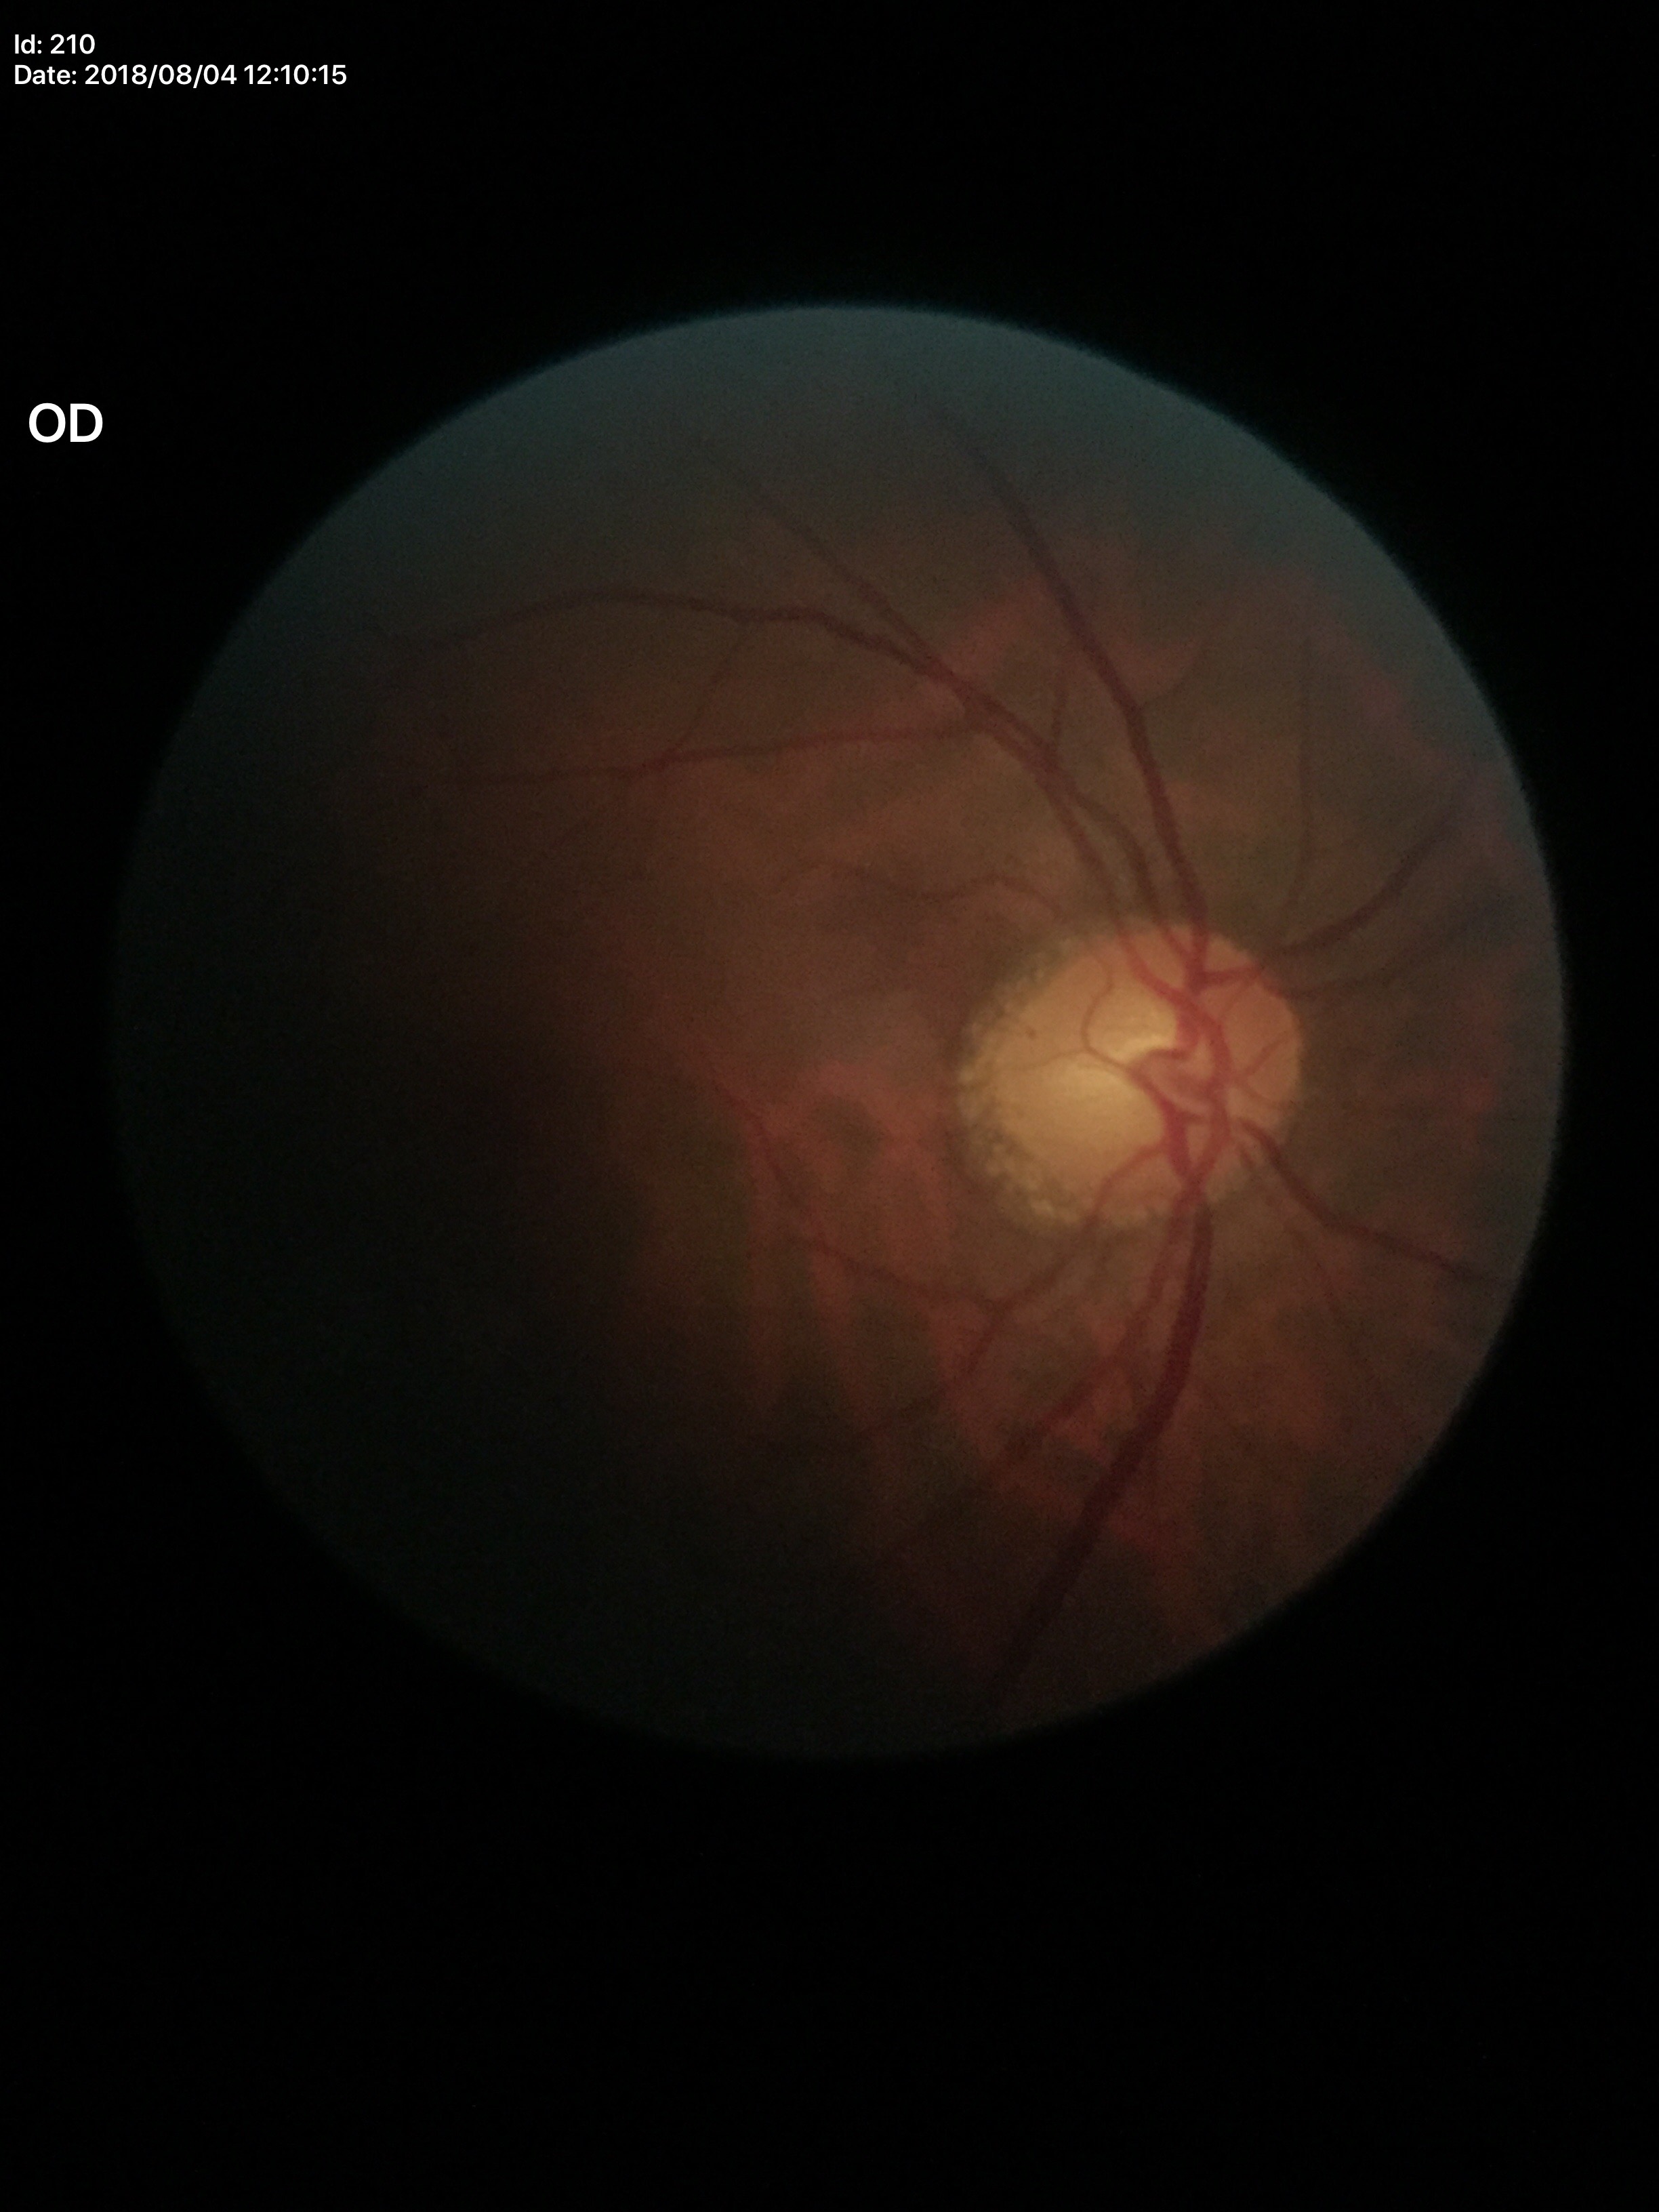

  glaucoma_decision: no suspicious findings (one of five ophthalmologists flagged glaucoma suspect)
  hcdr: 0.57
  acdr: 0.30
  vcdr: 0.54